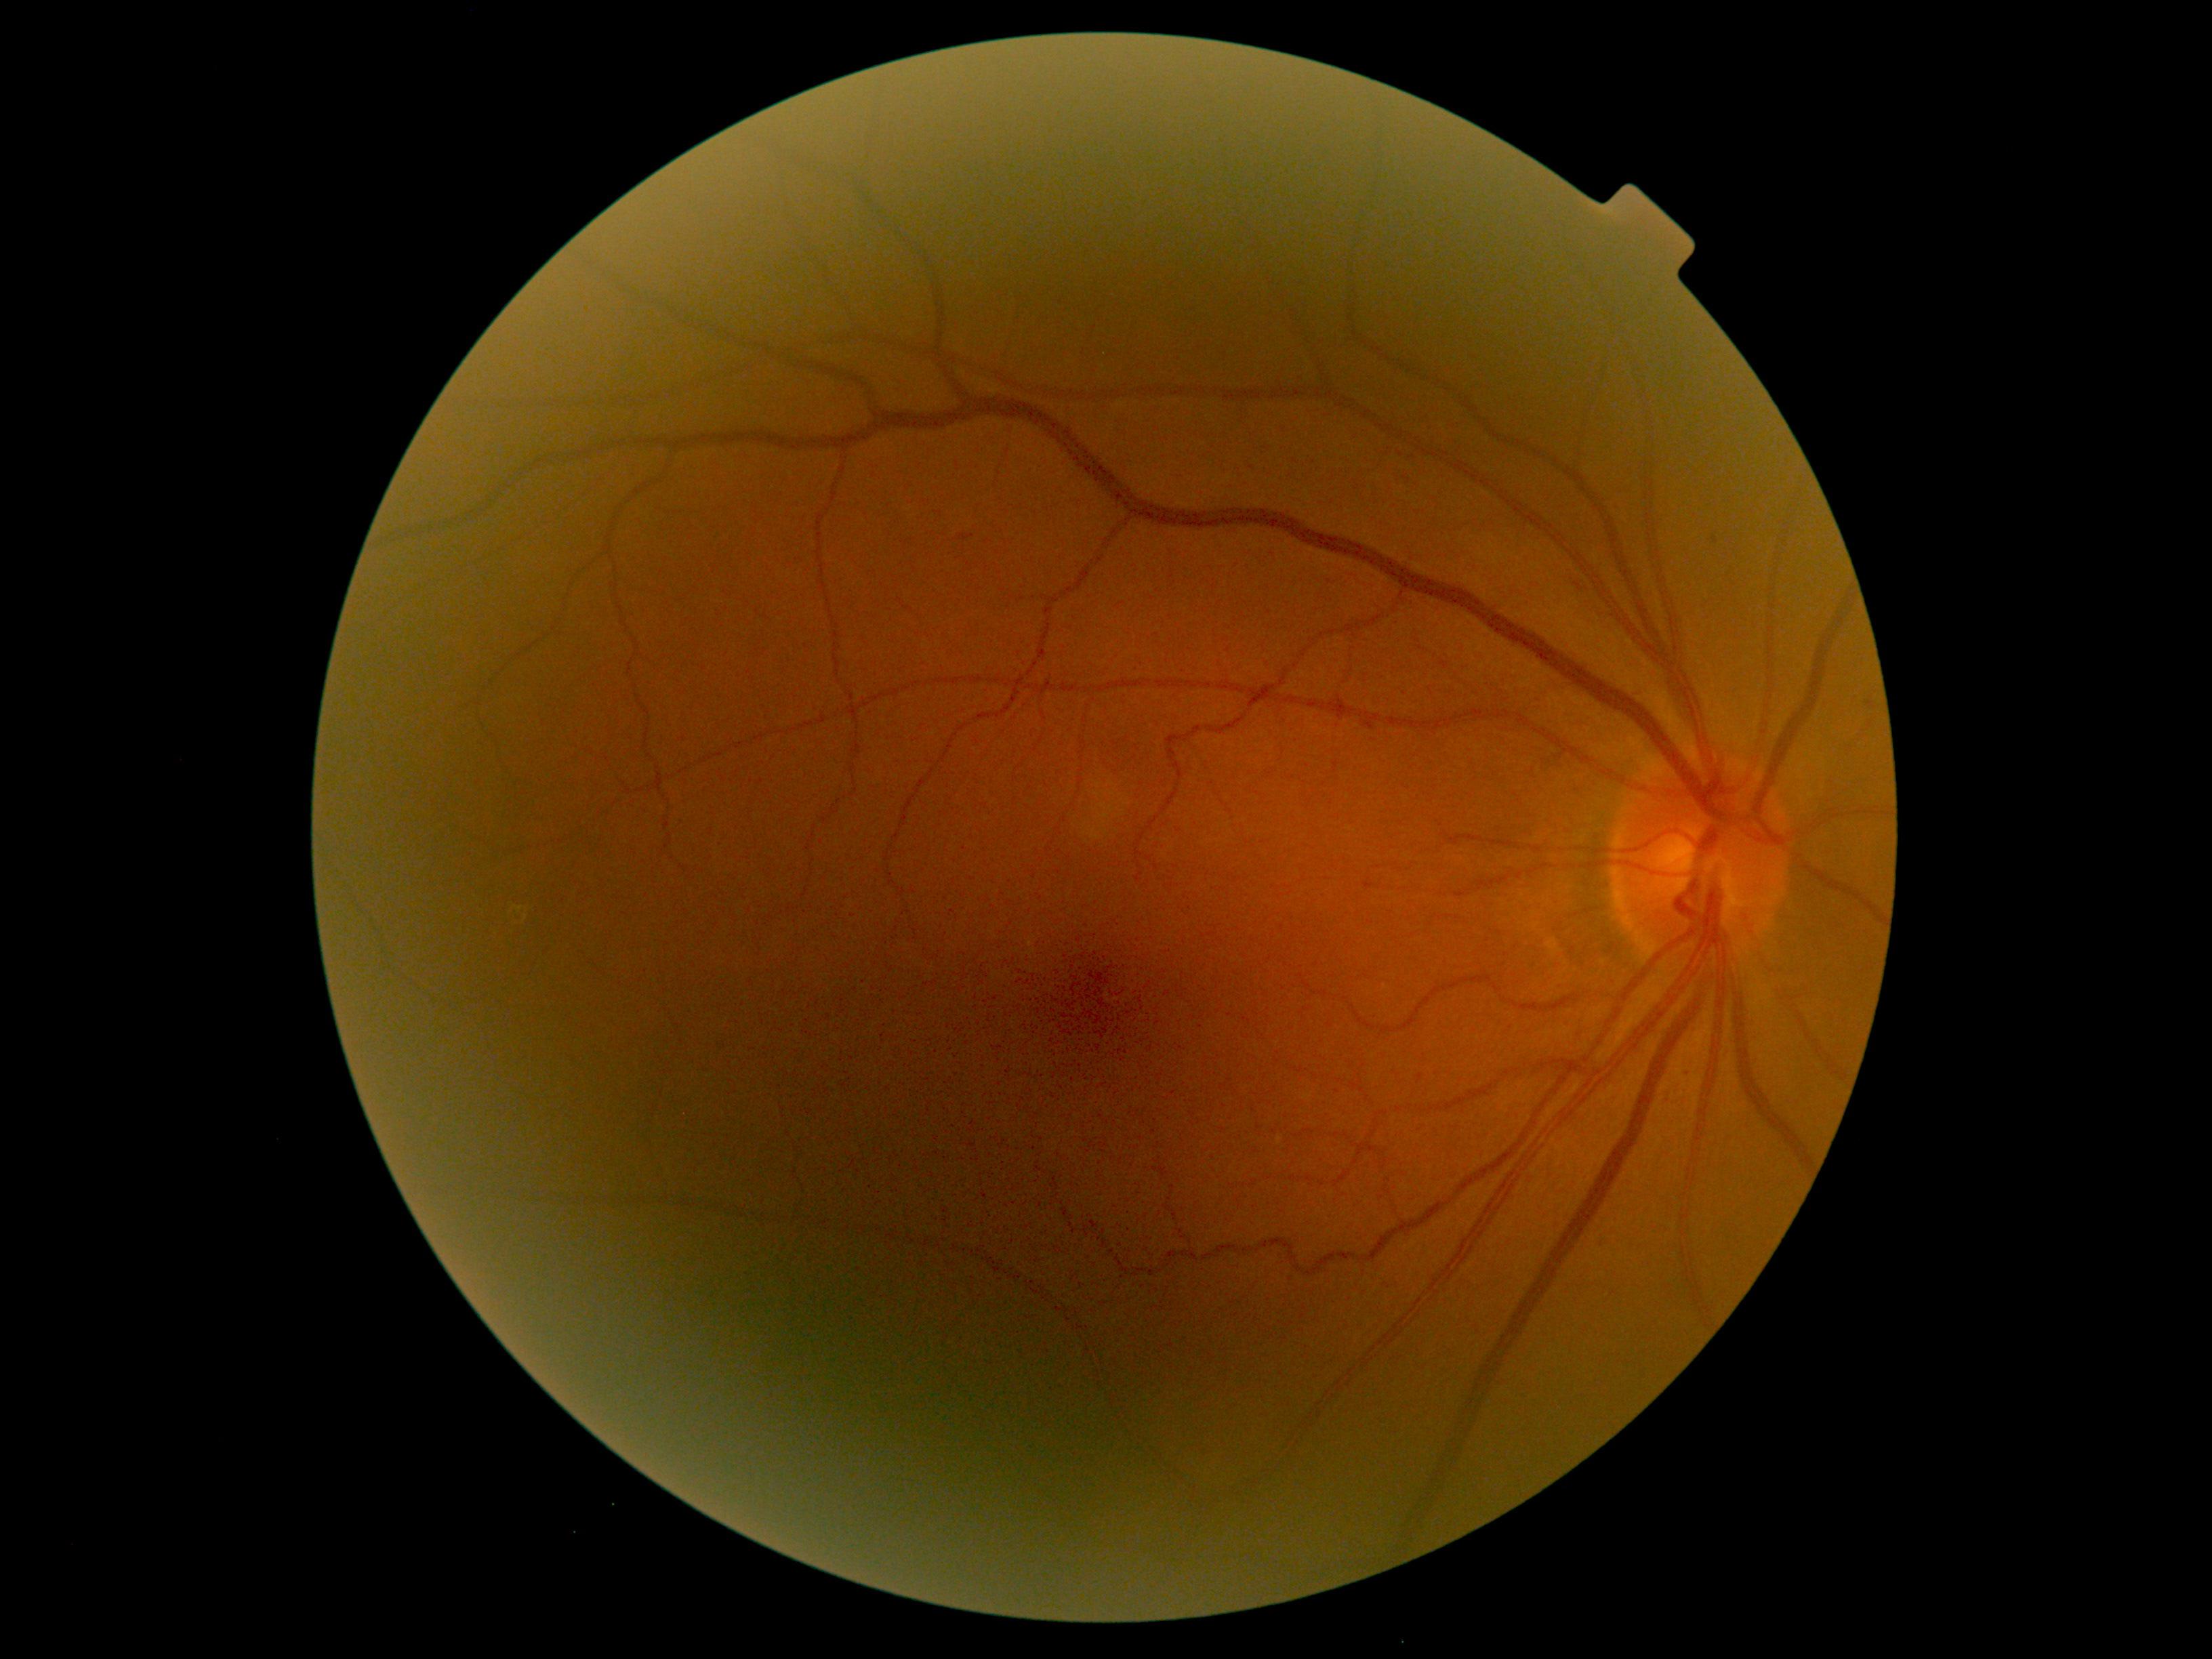

Diabetic retinopathy severity is grade 1 (mild NPDR).